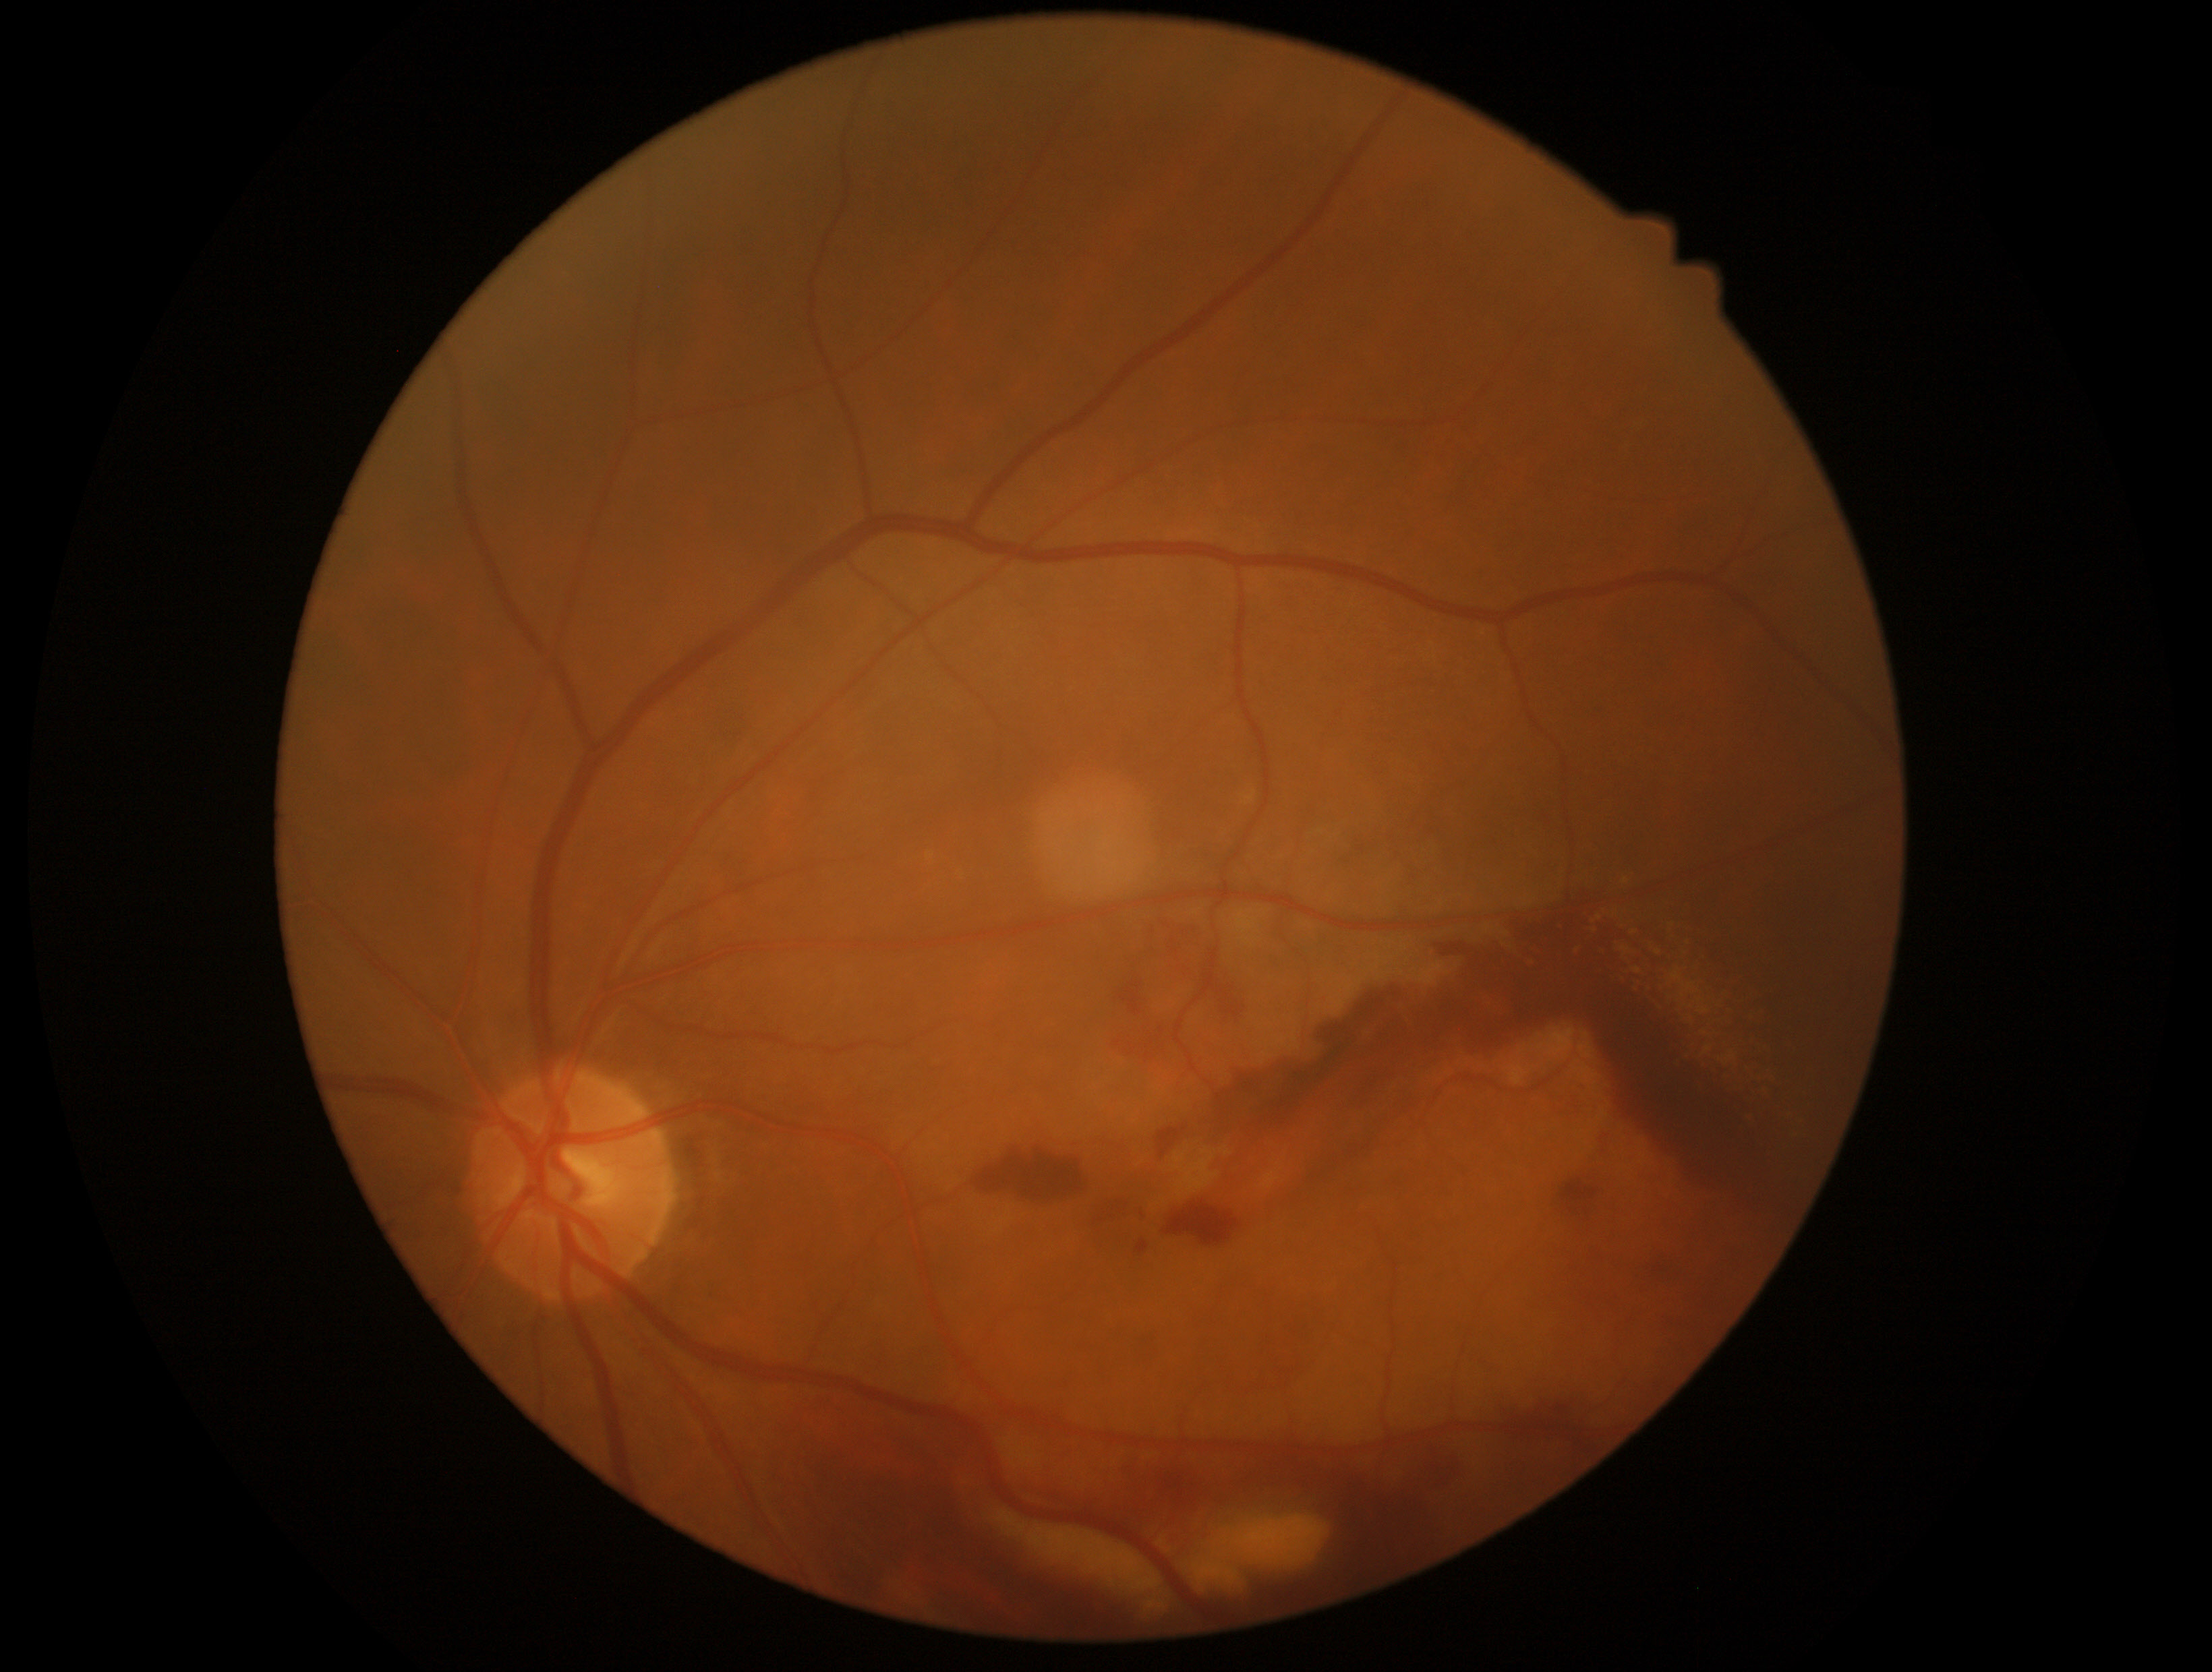
Diabetic retinopathy: grade 4. DR class: proliferative diabetic retinopathy.